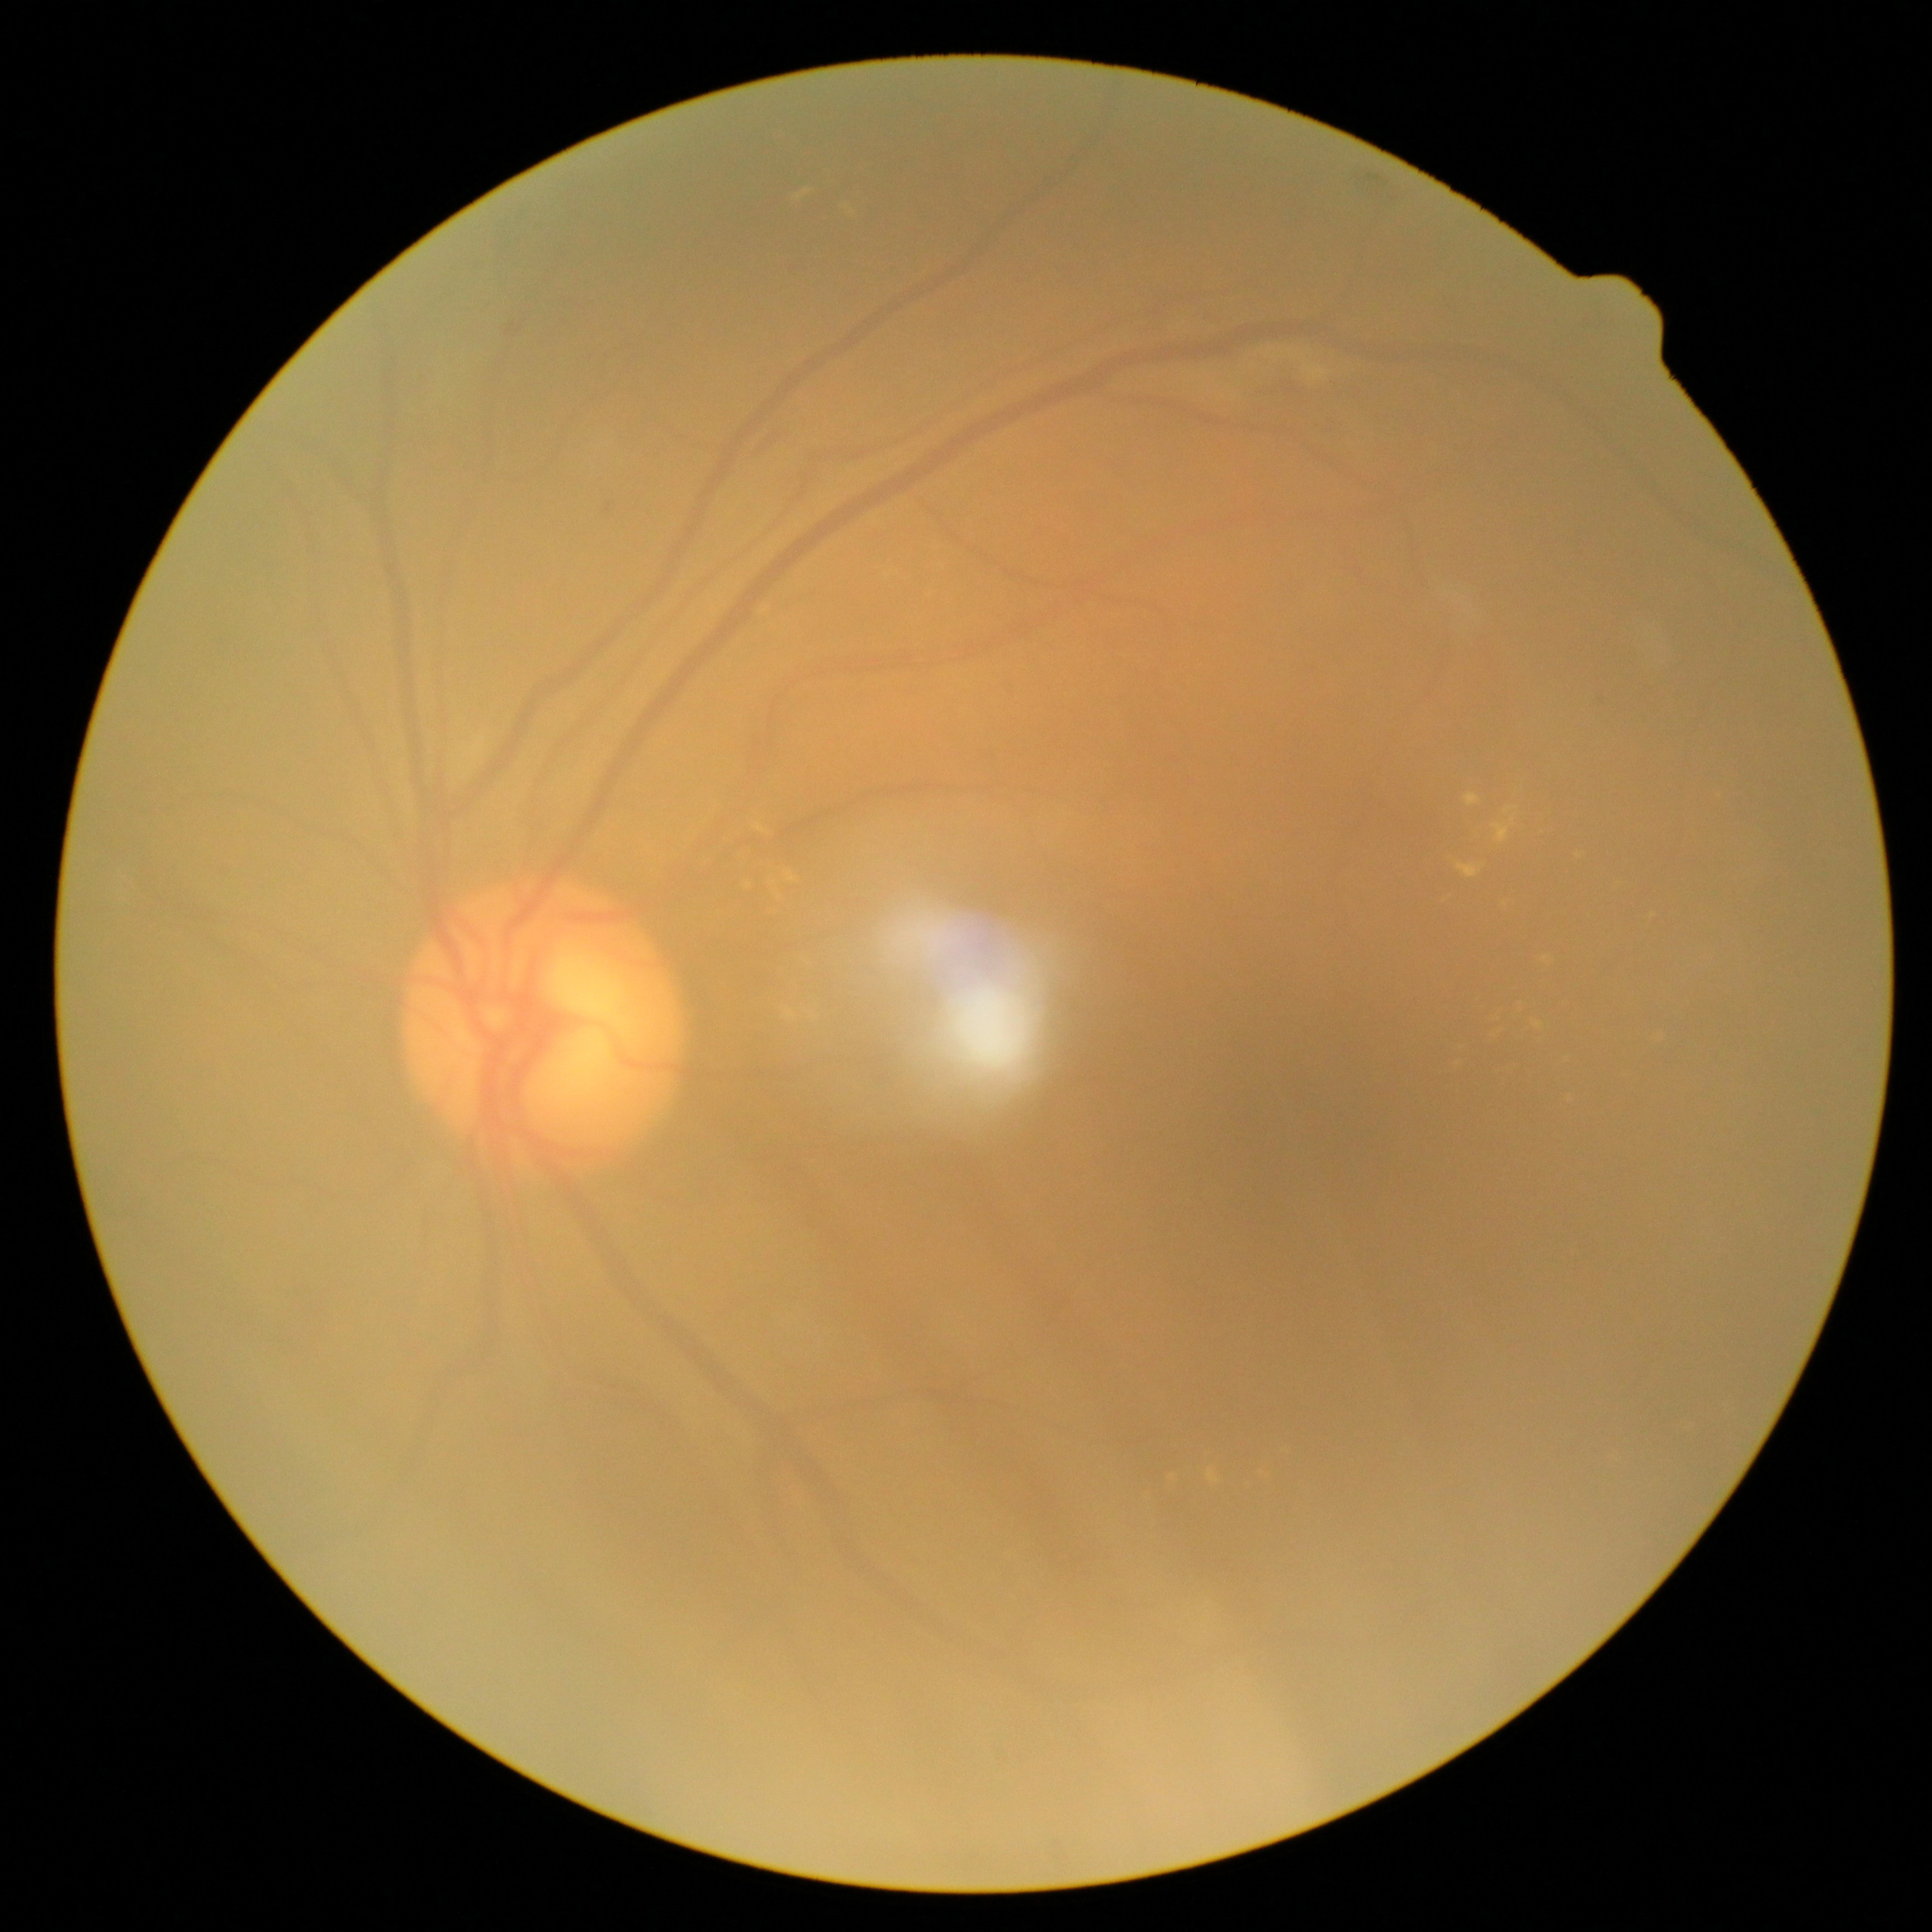
The retinopathy is classified as non-proliferative diabetic retinopathy.
Retinopathy grade: moderate non-proliferative diabetic retinopathy (2).